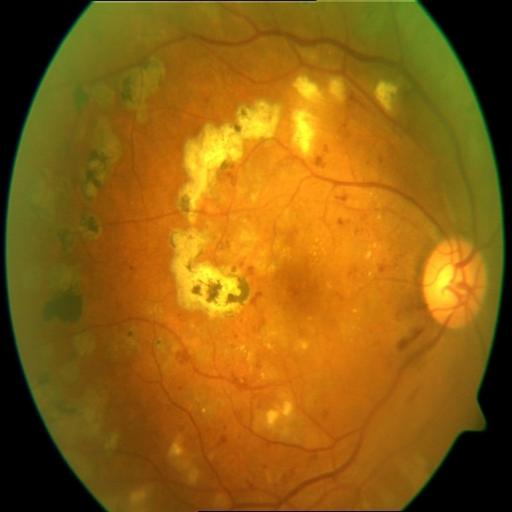 Findings consistent with LS (laser scars) & HR (hemorrhagic retinopathy).